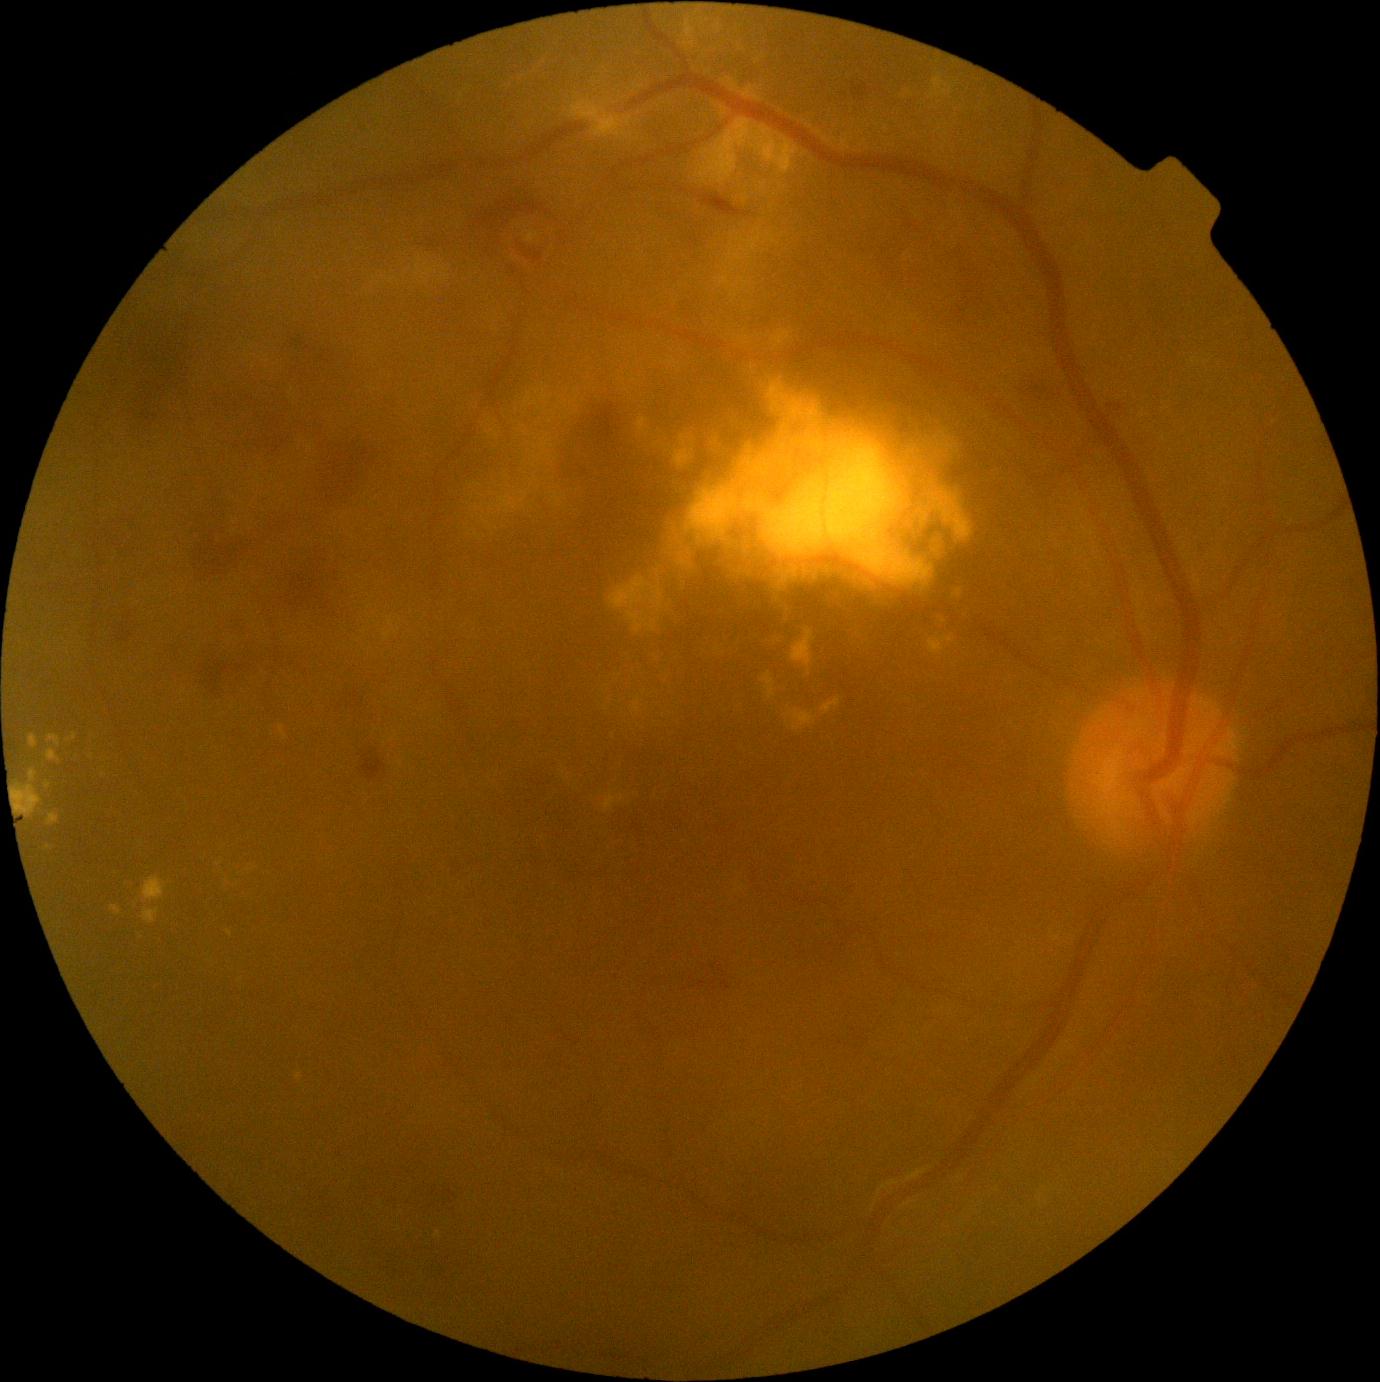

dr_category: non-proliferative diabetic retinopathy
dr_grade: 2 — more than just microaneurysms but less than severe NPDR